Color fundus image, 2352x1568px
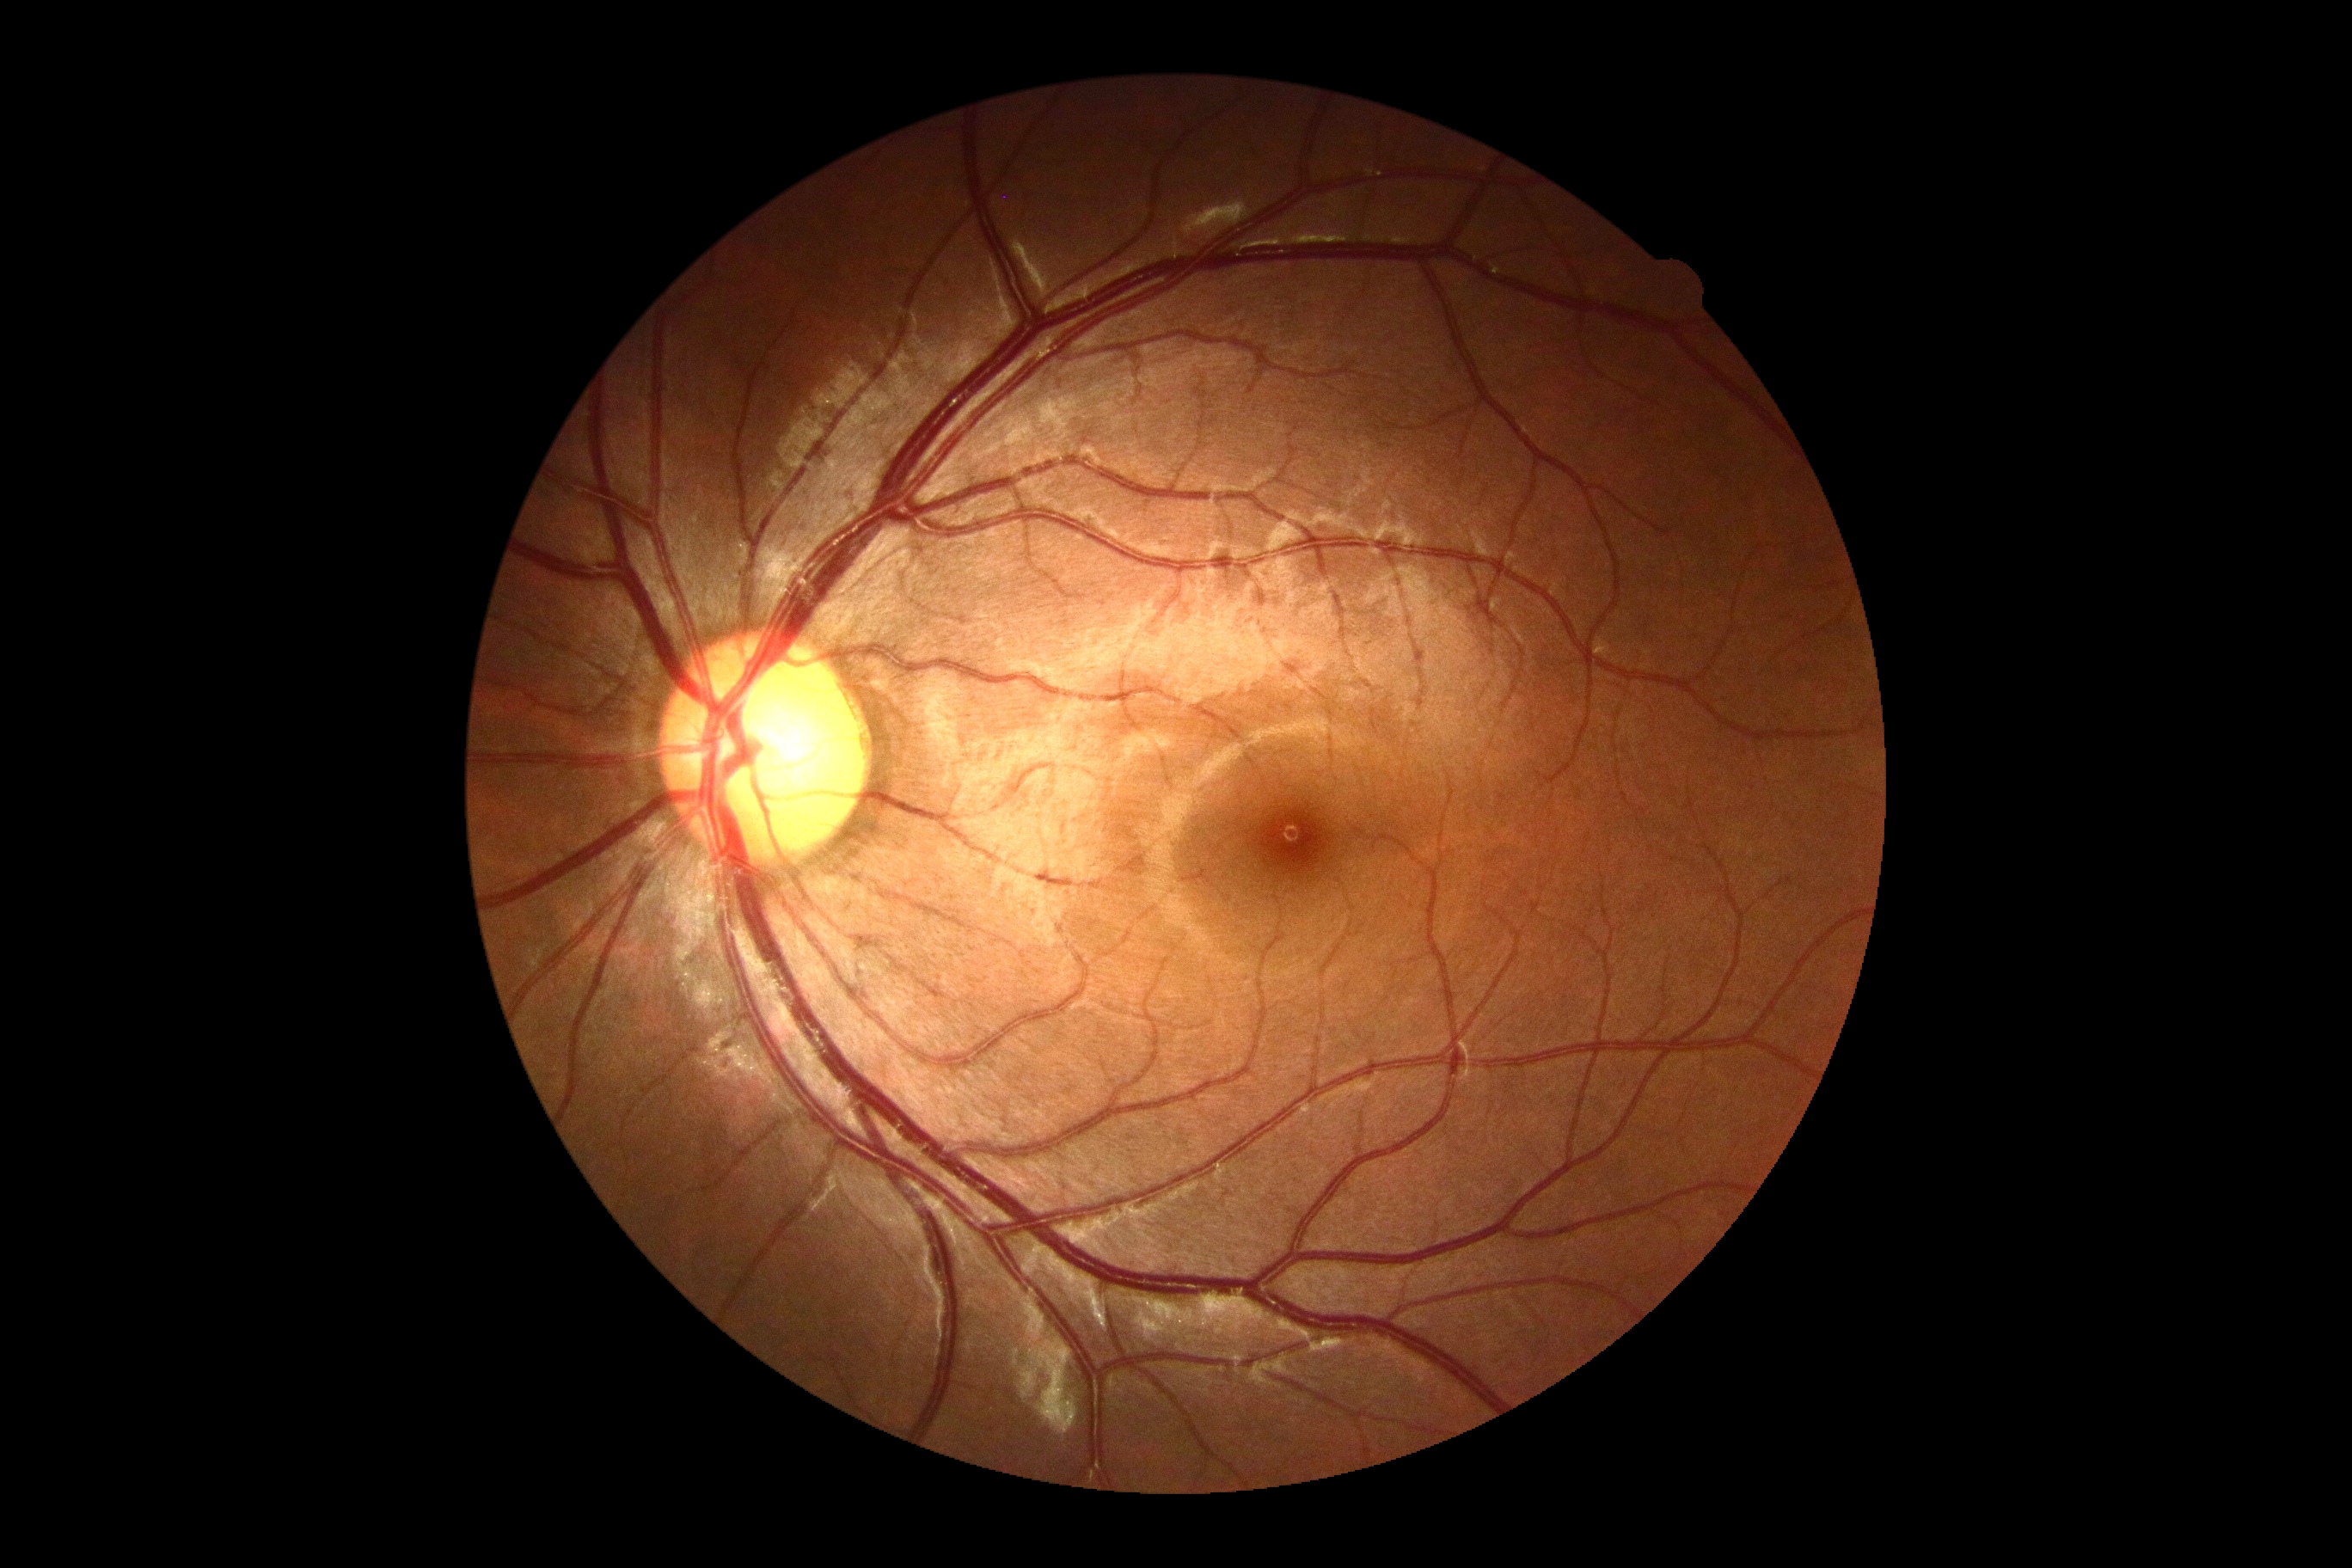 {
  "dr_grade": "no apparent diabetic retinopathy (grade 0)"
}